848 by 848 pixels.
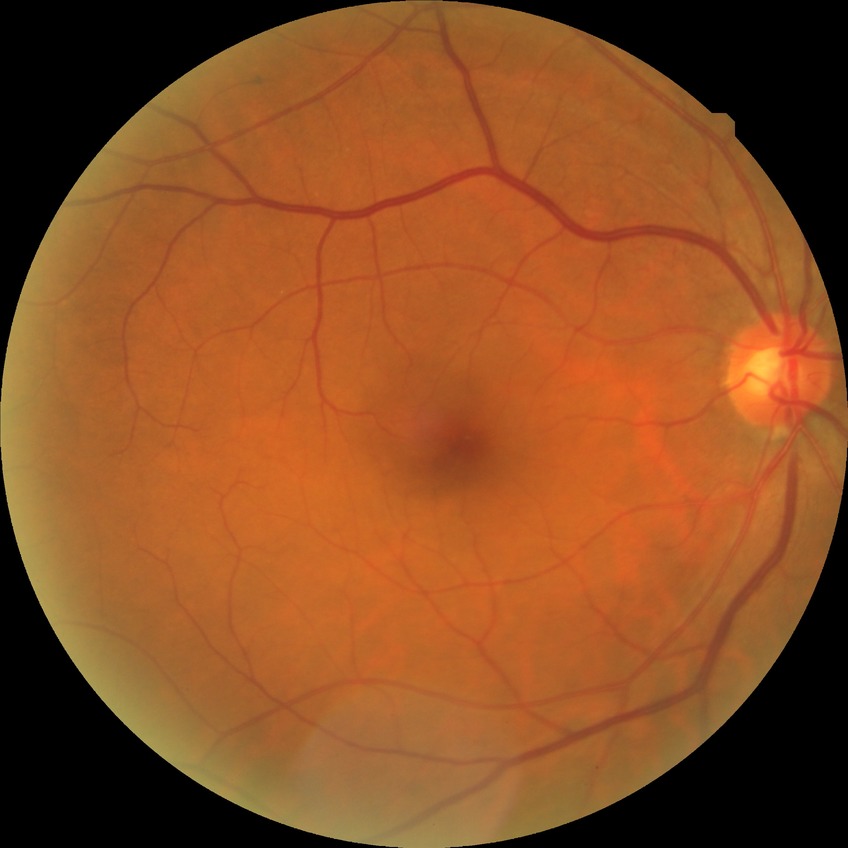 Diabetic retinopathy (DR) is NDR (no diabetic retinopathy).